Wide-field contact fundus photograph of an infant
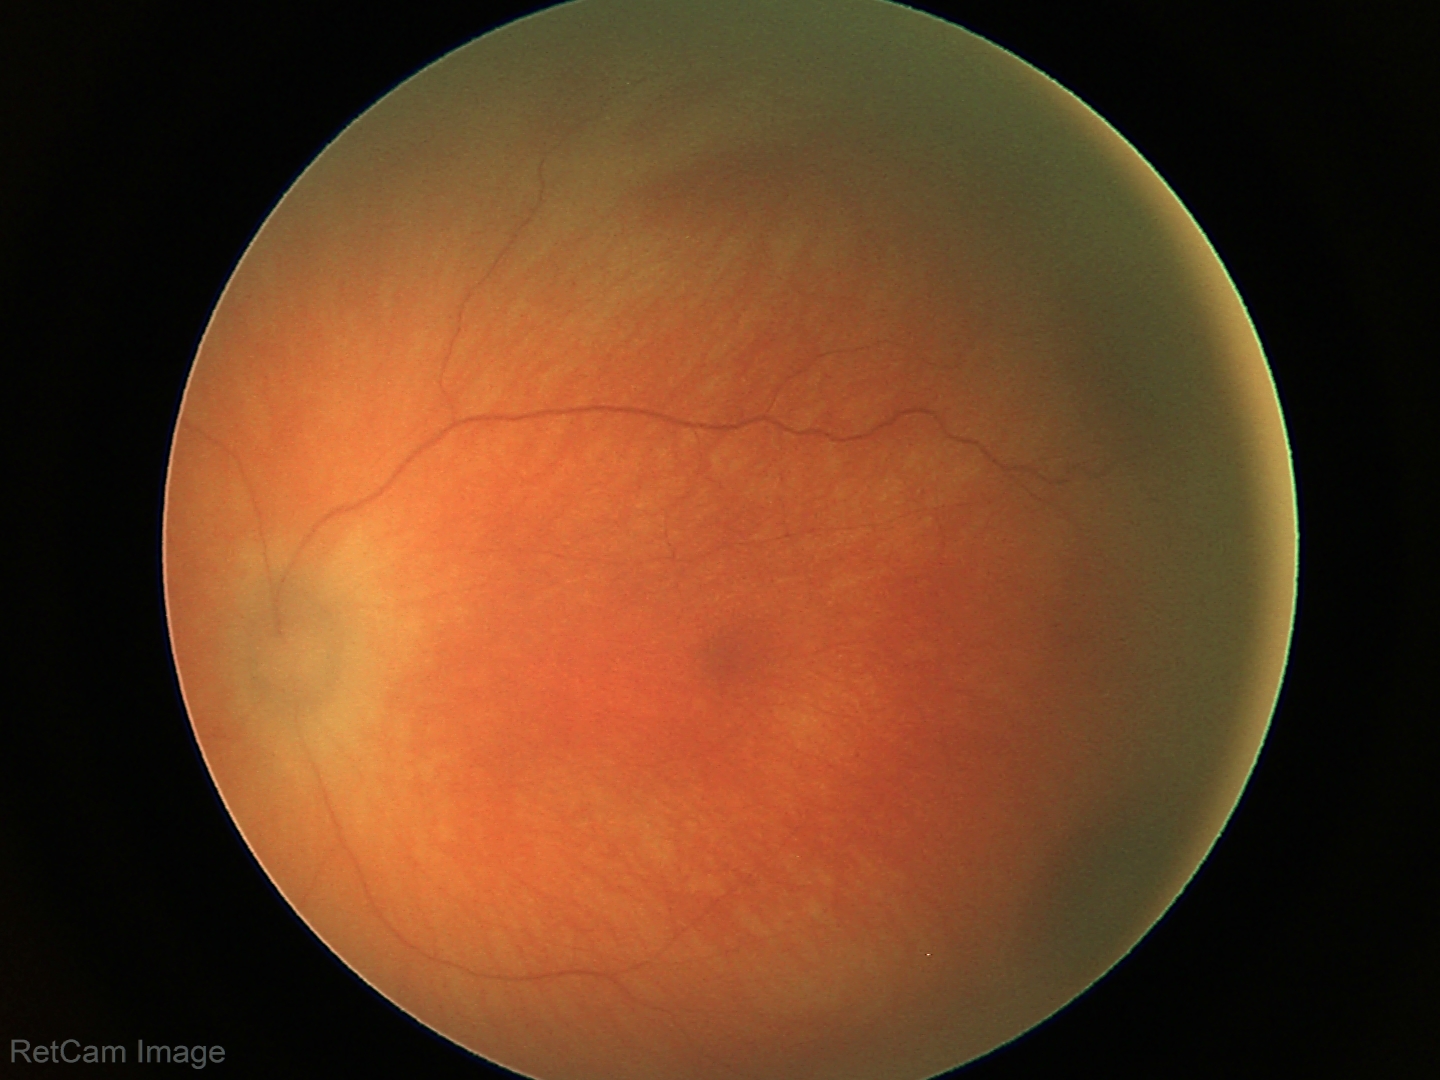 From an examination with diagnosis of retinal hemorrhages.